45° field of view — 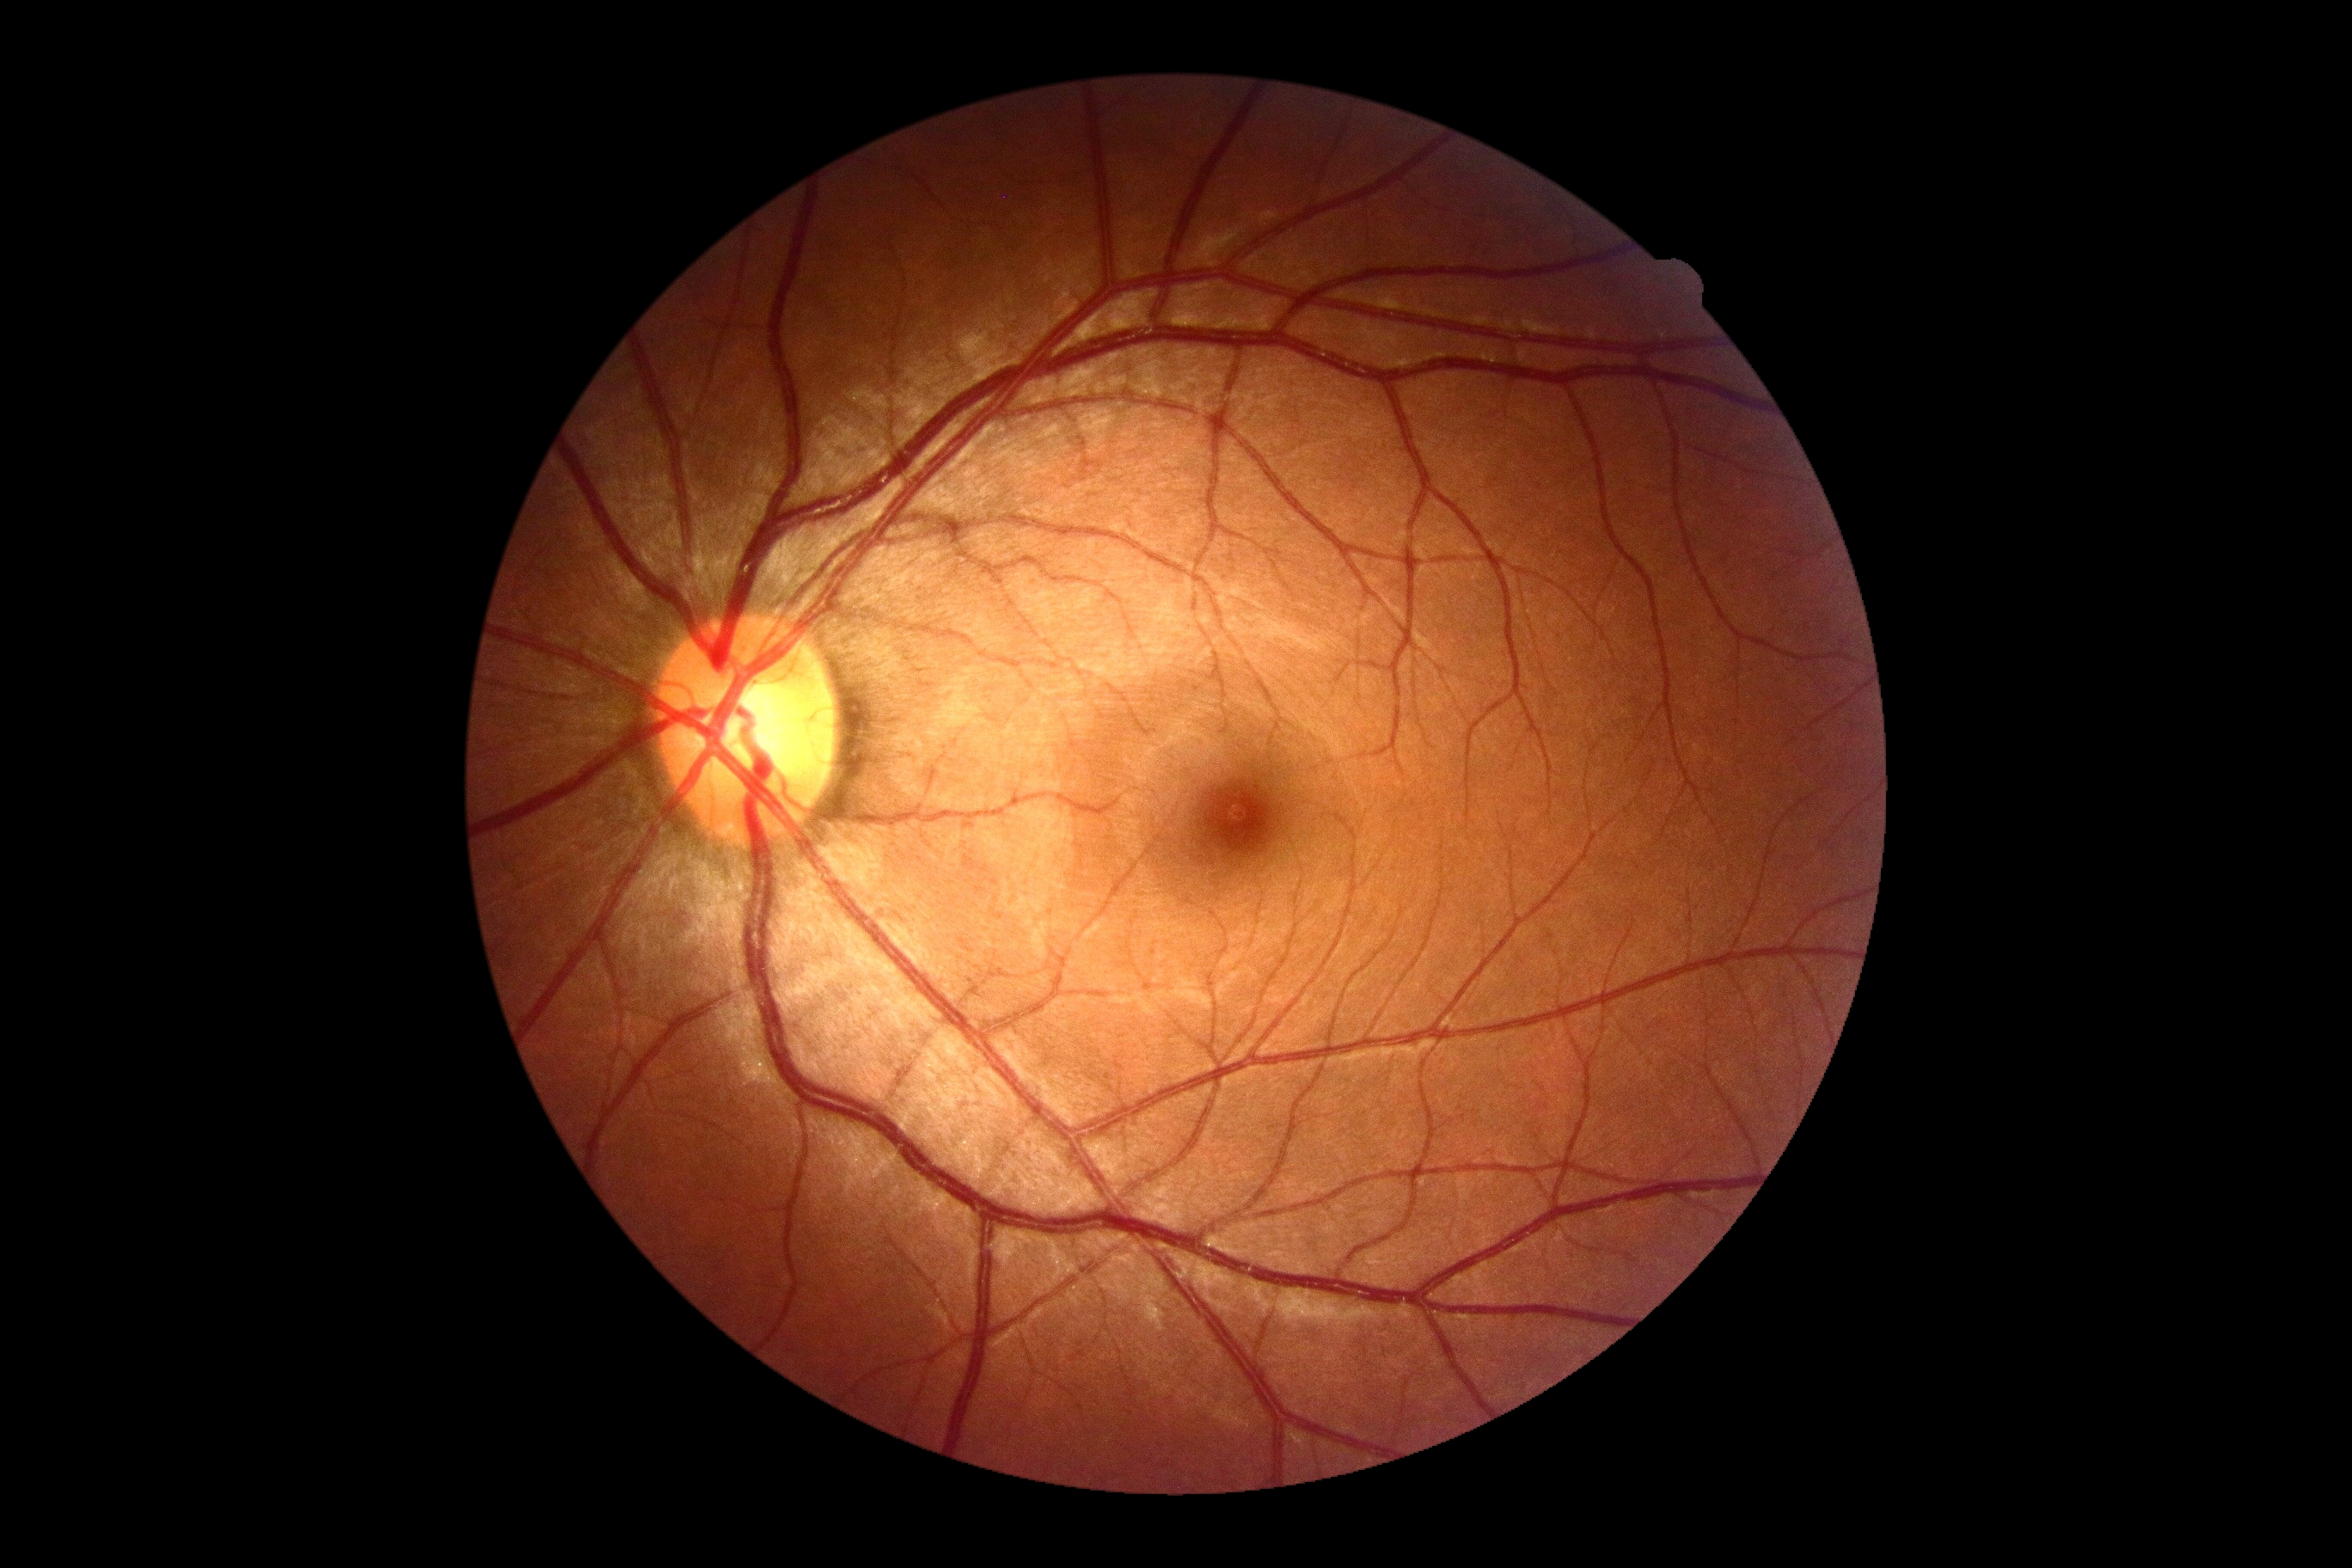
Diabetic retinopathy severity is grade 0 (no apparent retinopathy).